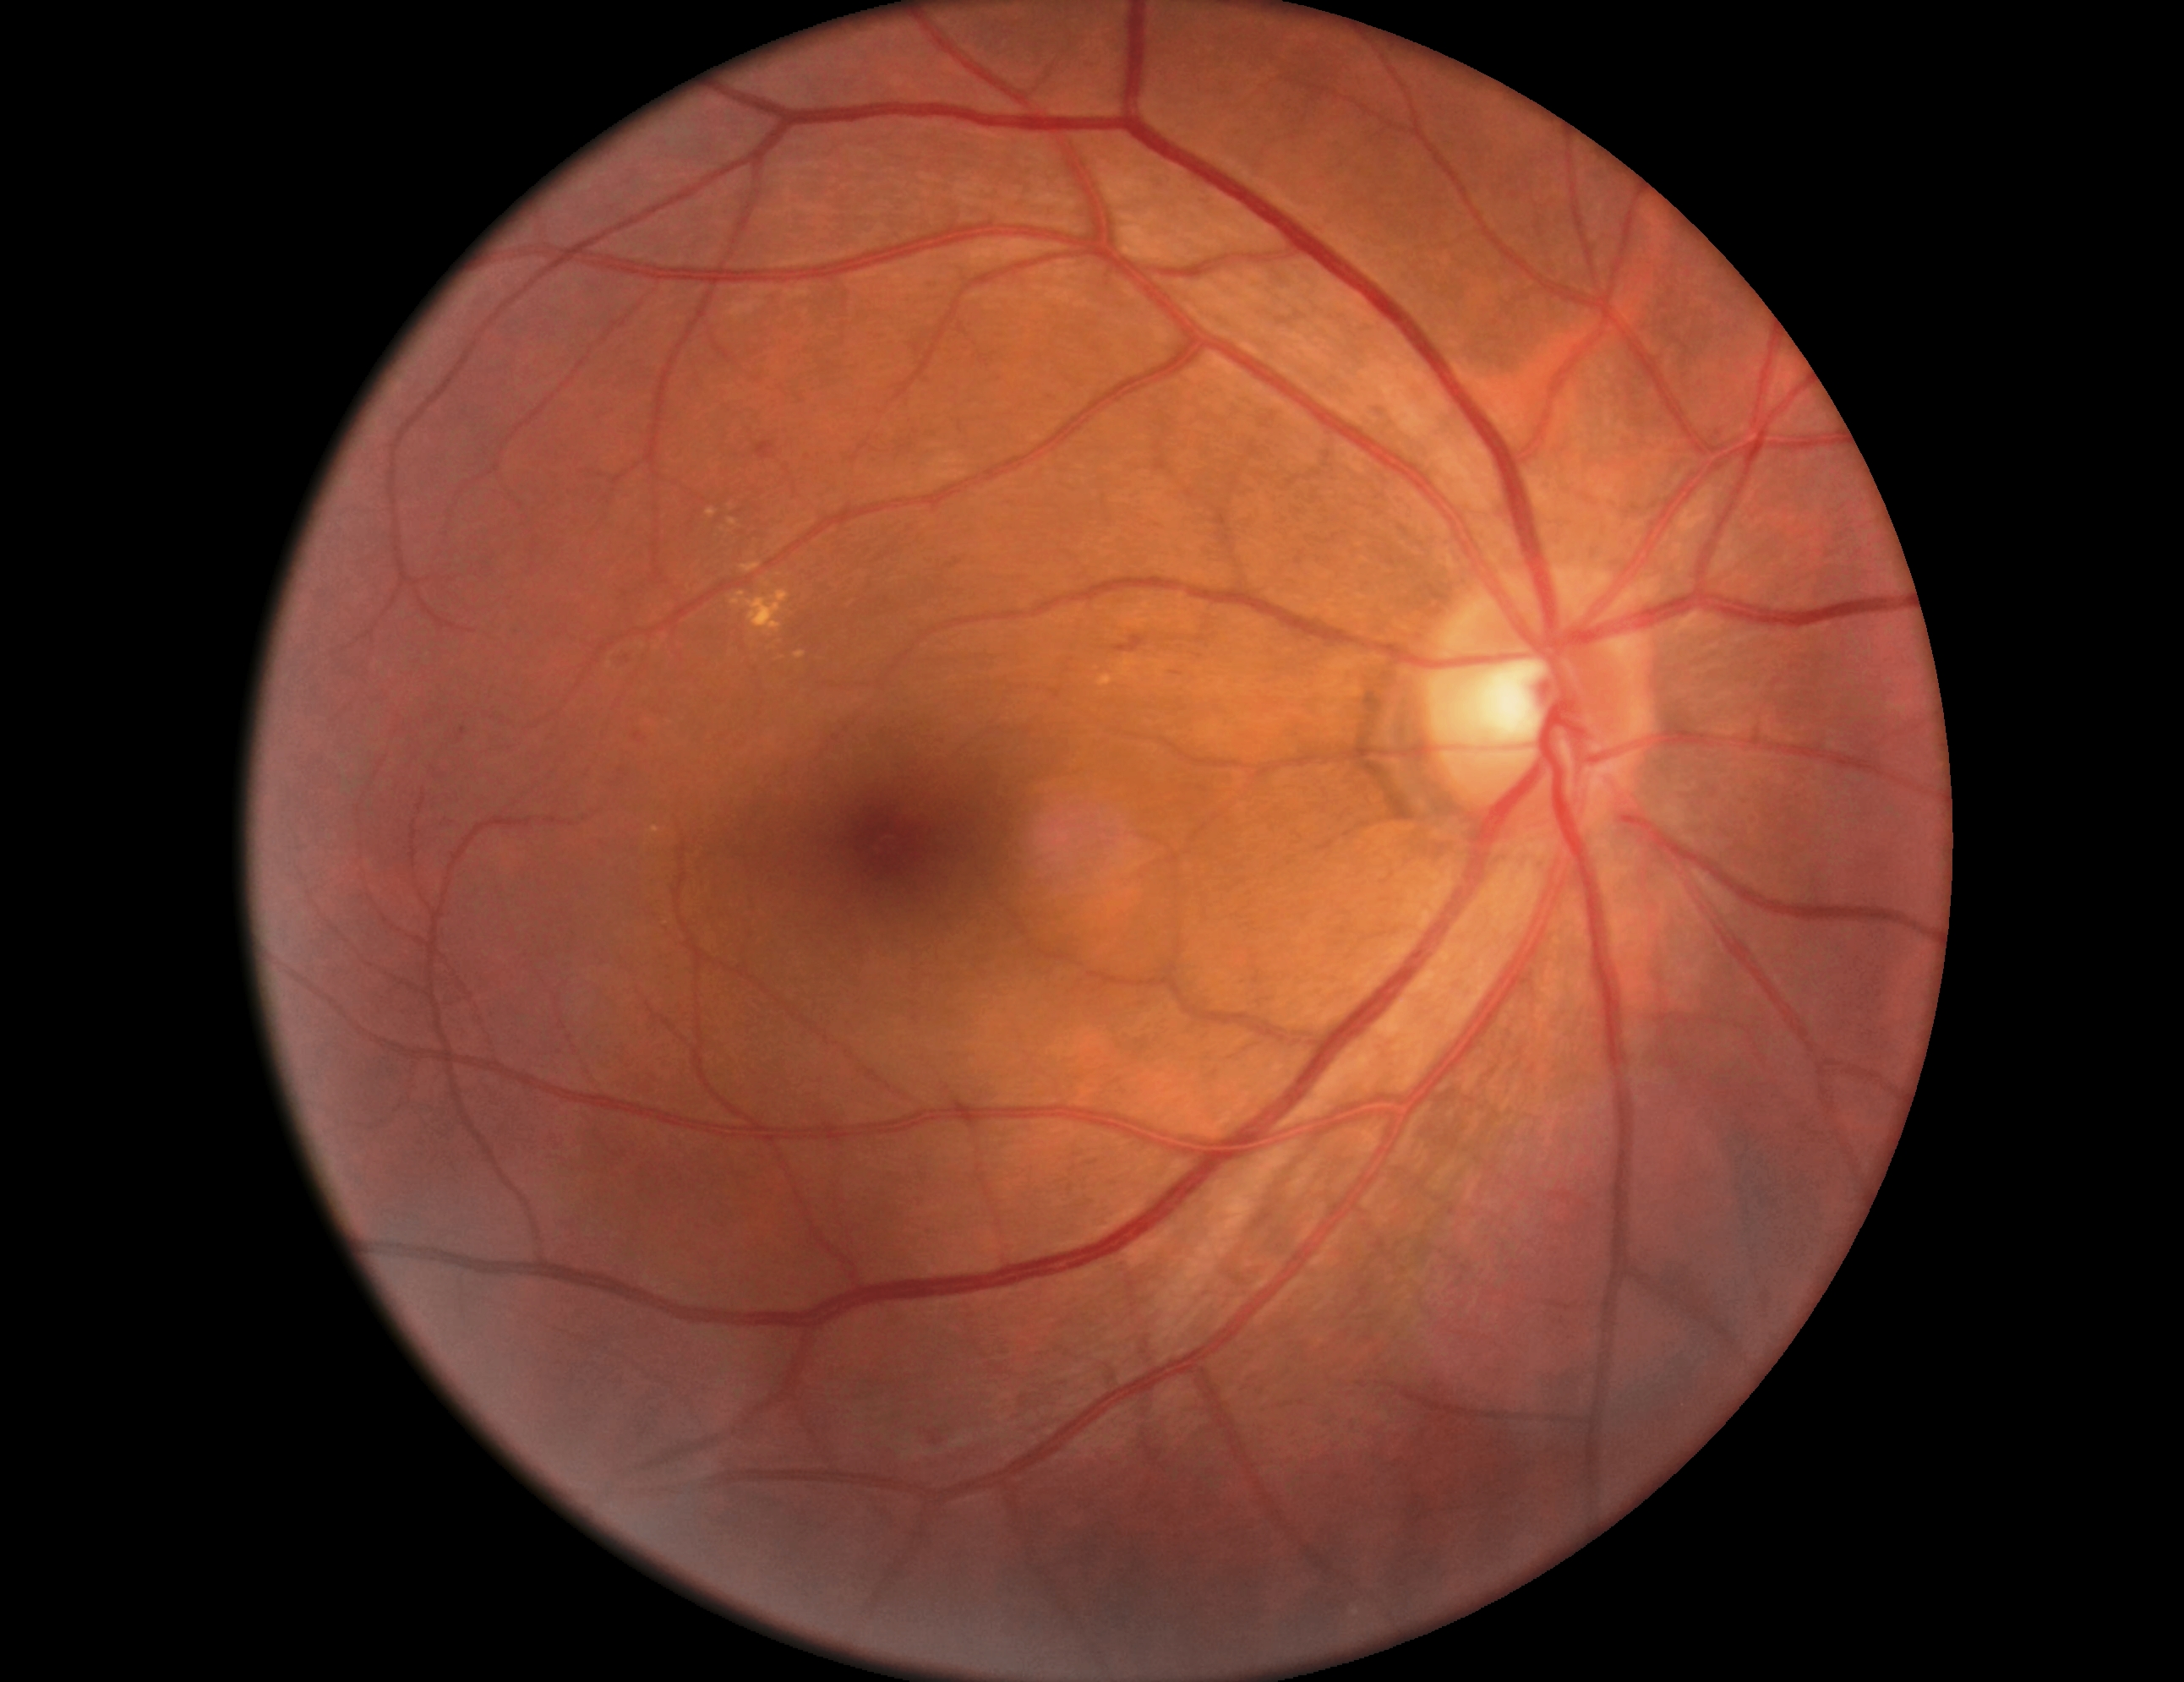 Diabetic retinopathy (DR): grade 2.